2352x1568:
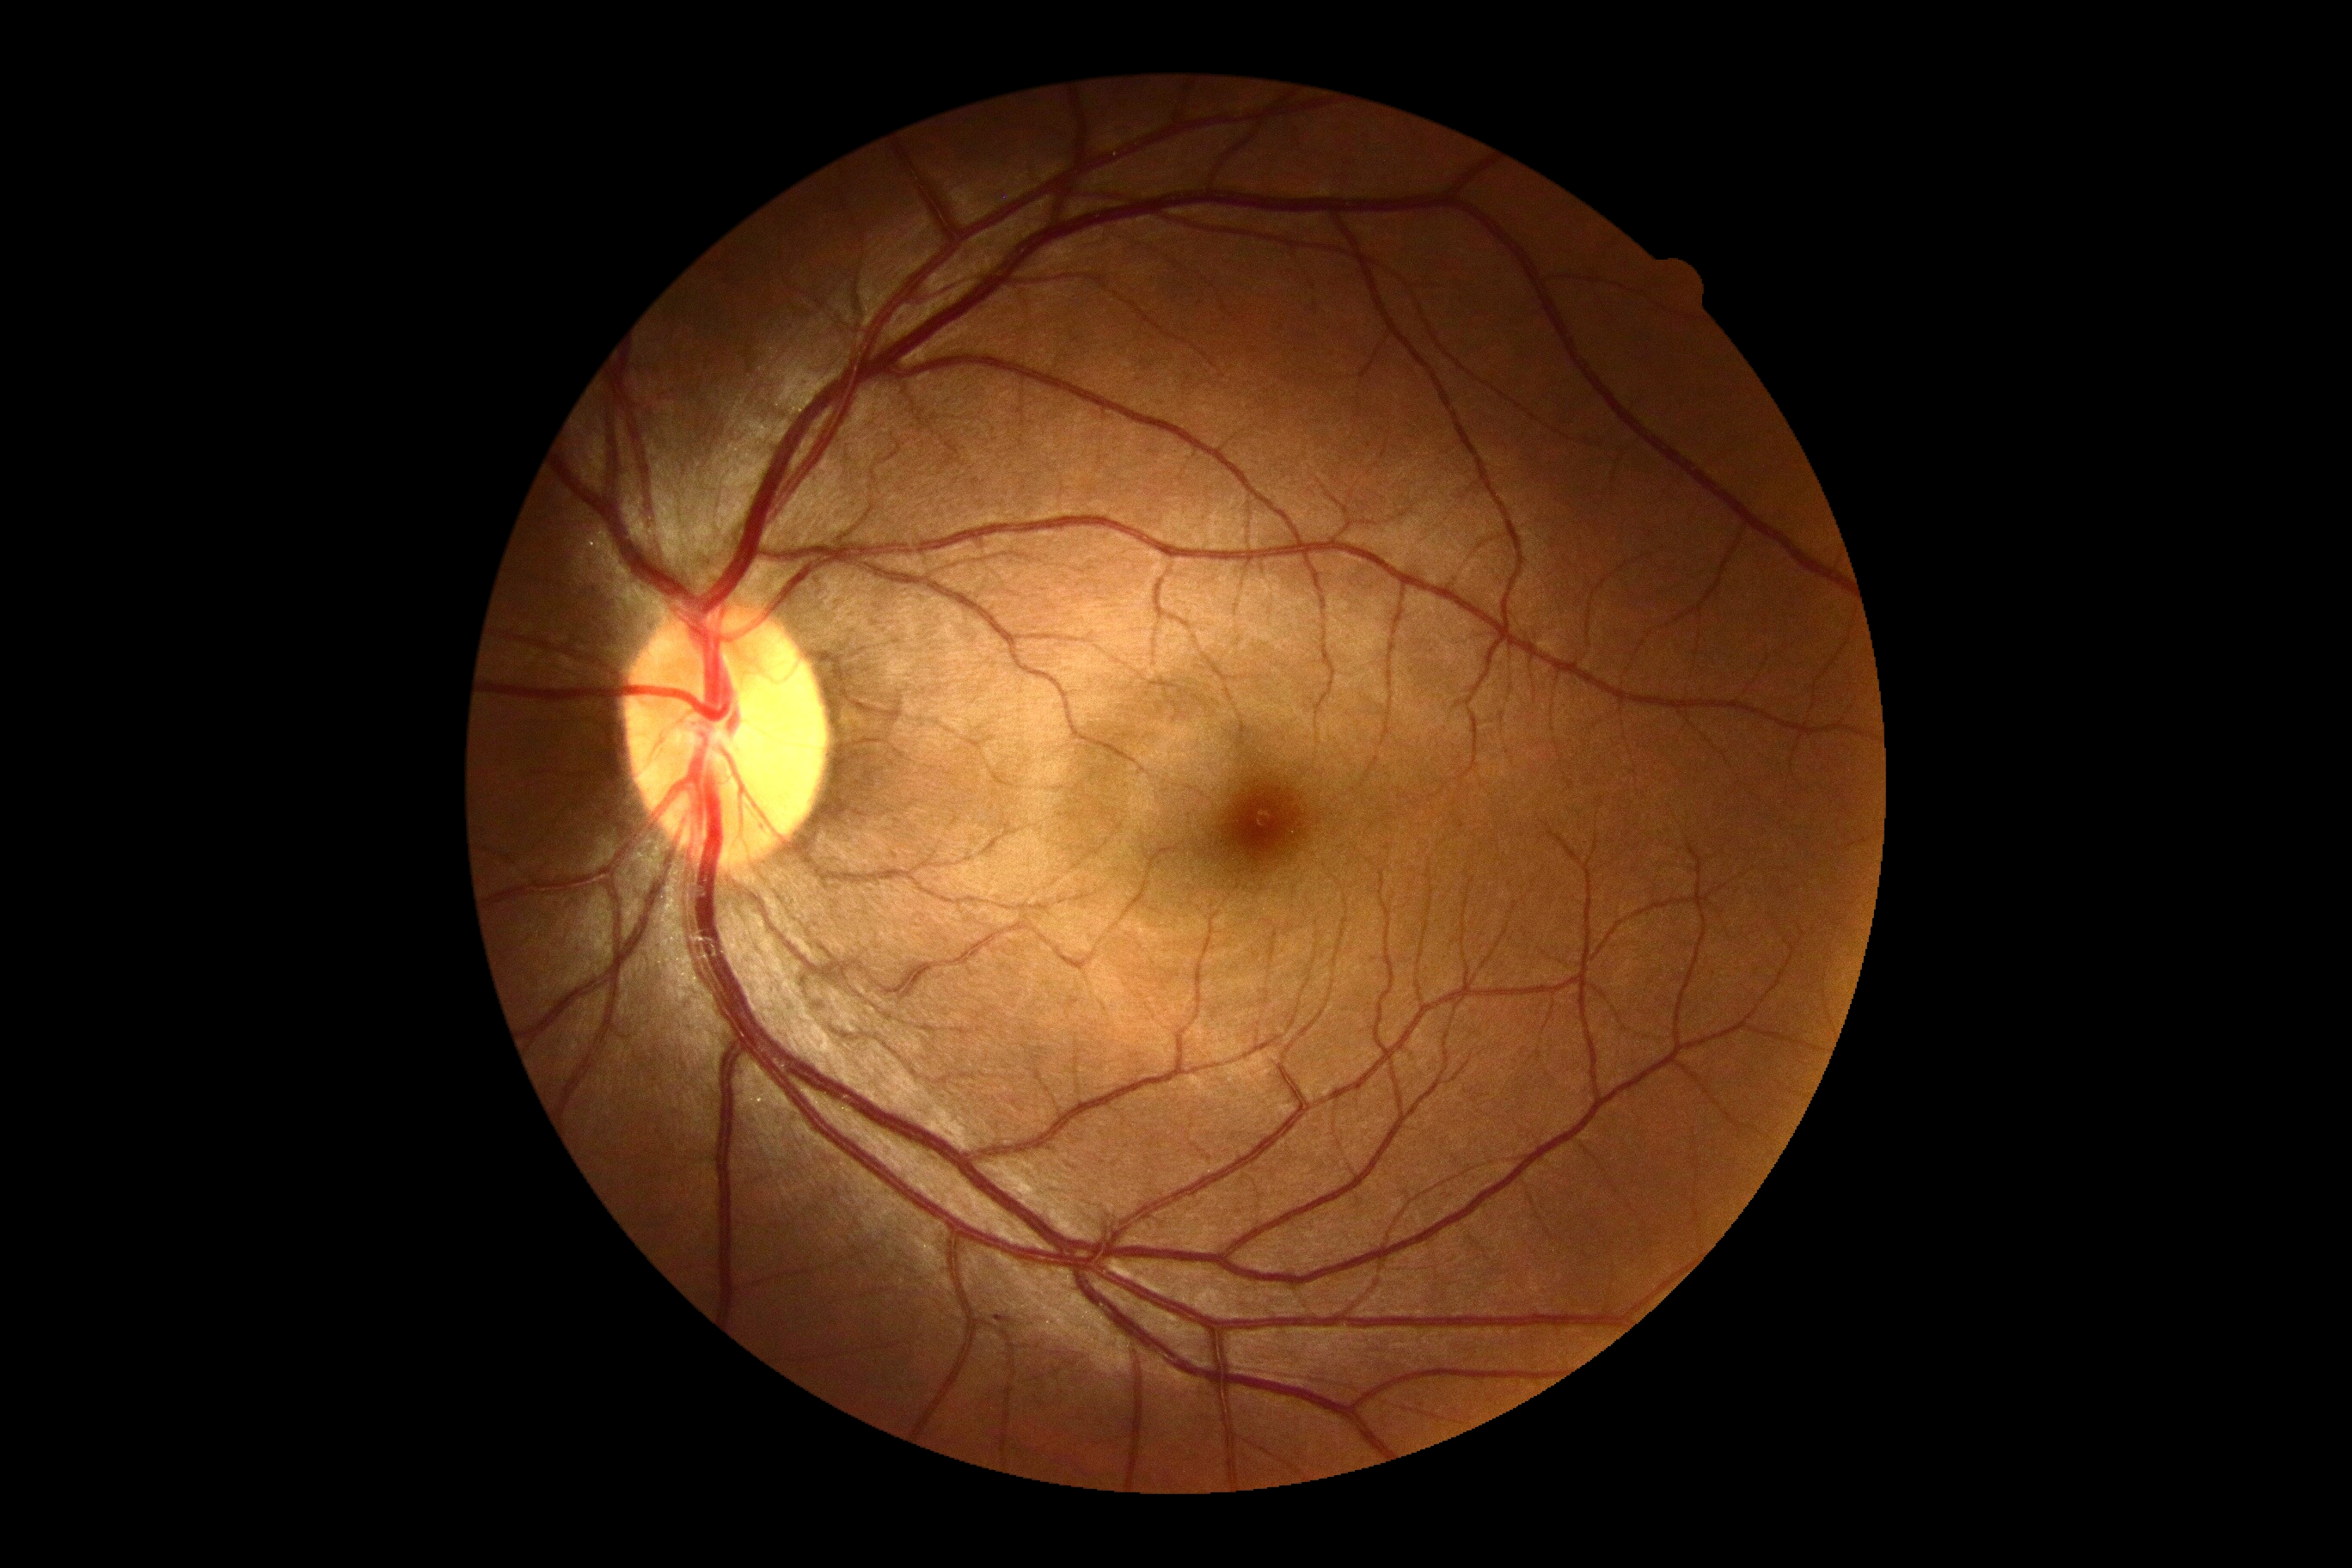

No signs of diabetic retinopathy. Retinopathy is 0 — no visible signs of diabetic retinopathy.